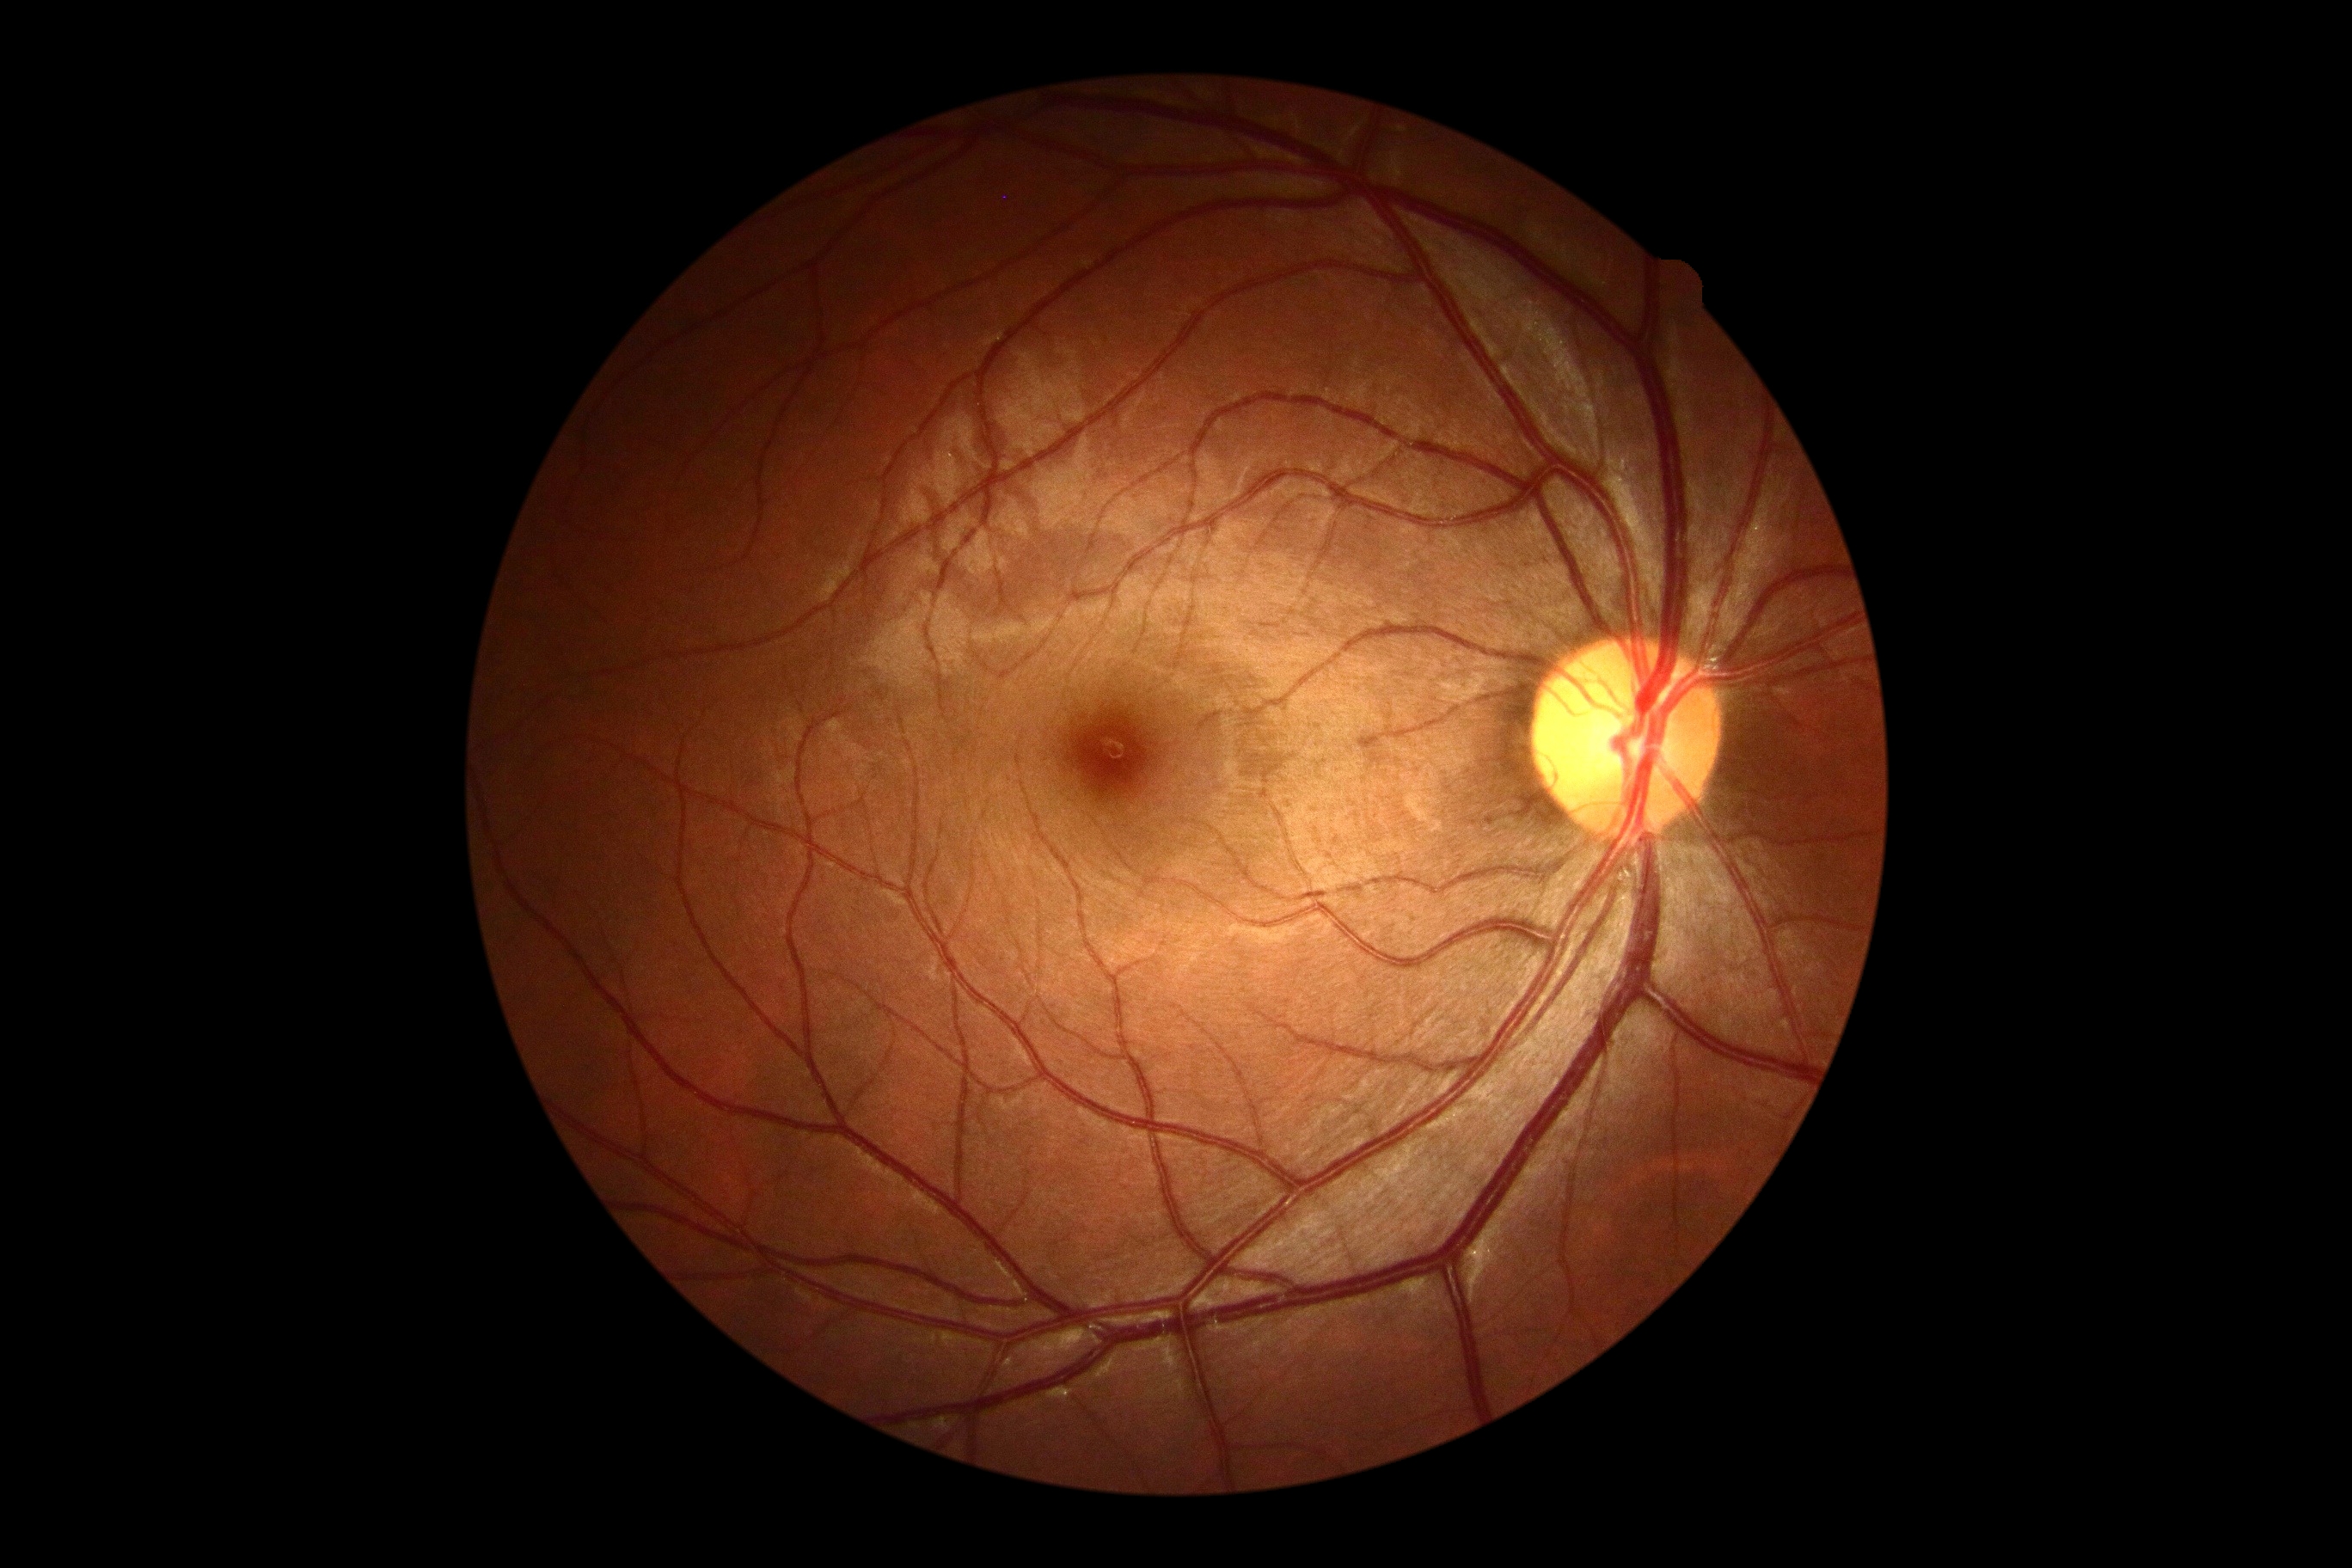 DR impression = no signs of DR; diabetic retinopathy = no apparent retinopathy (grade 0).